45-degree field of view; 2352x1568px; color fundus photograph:
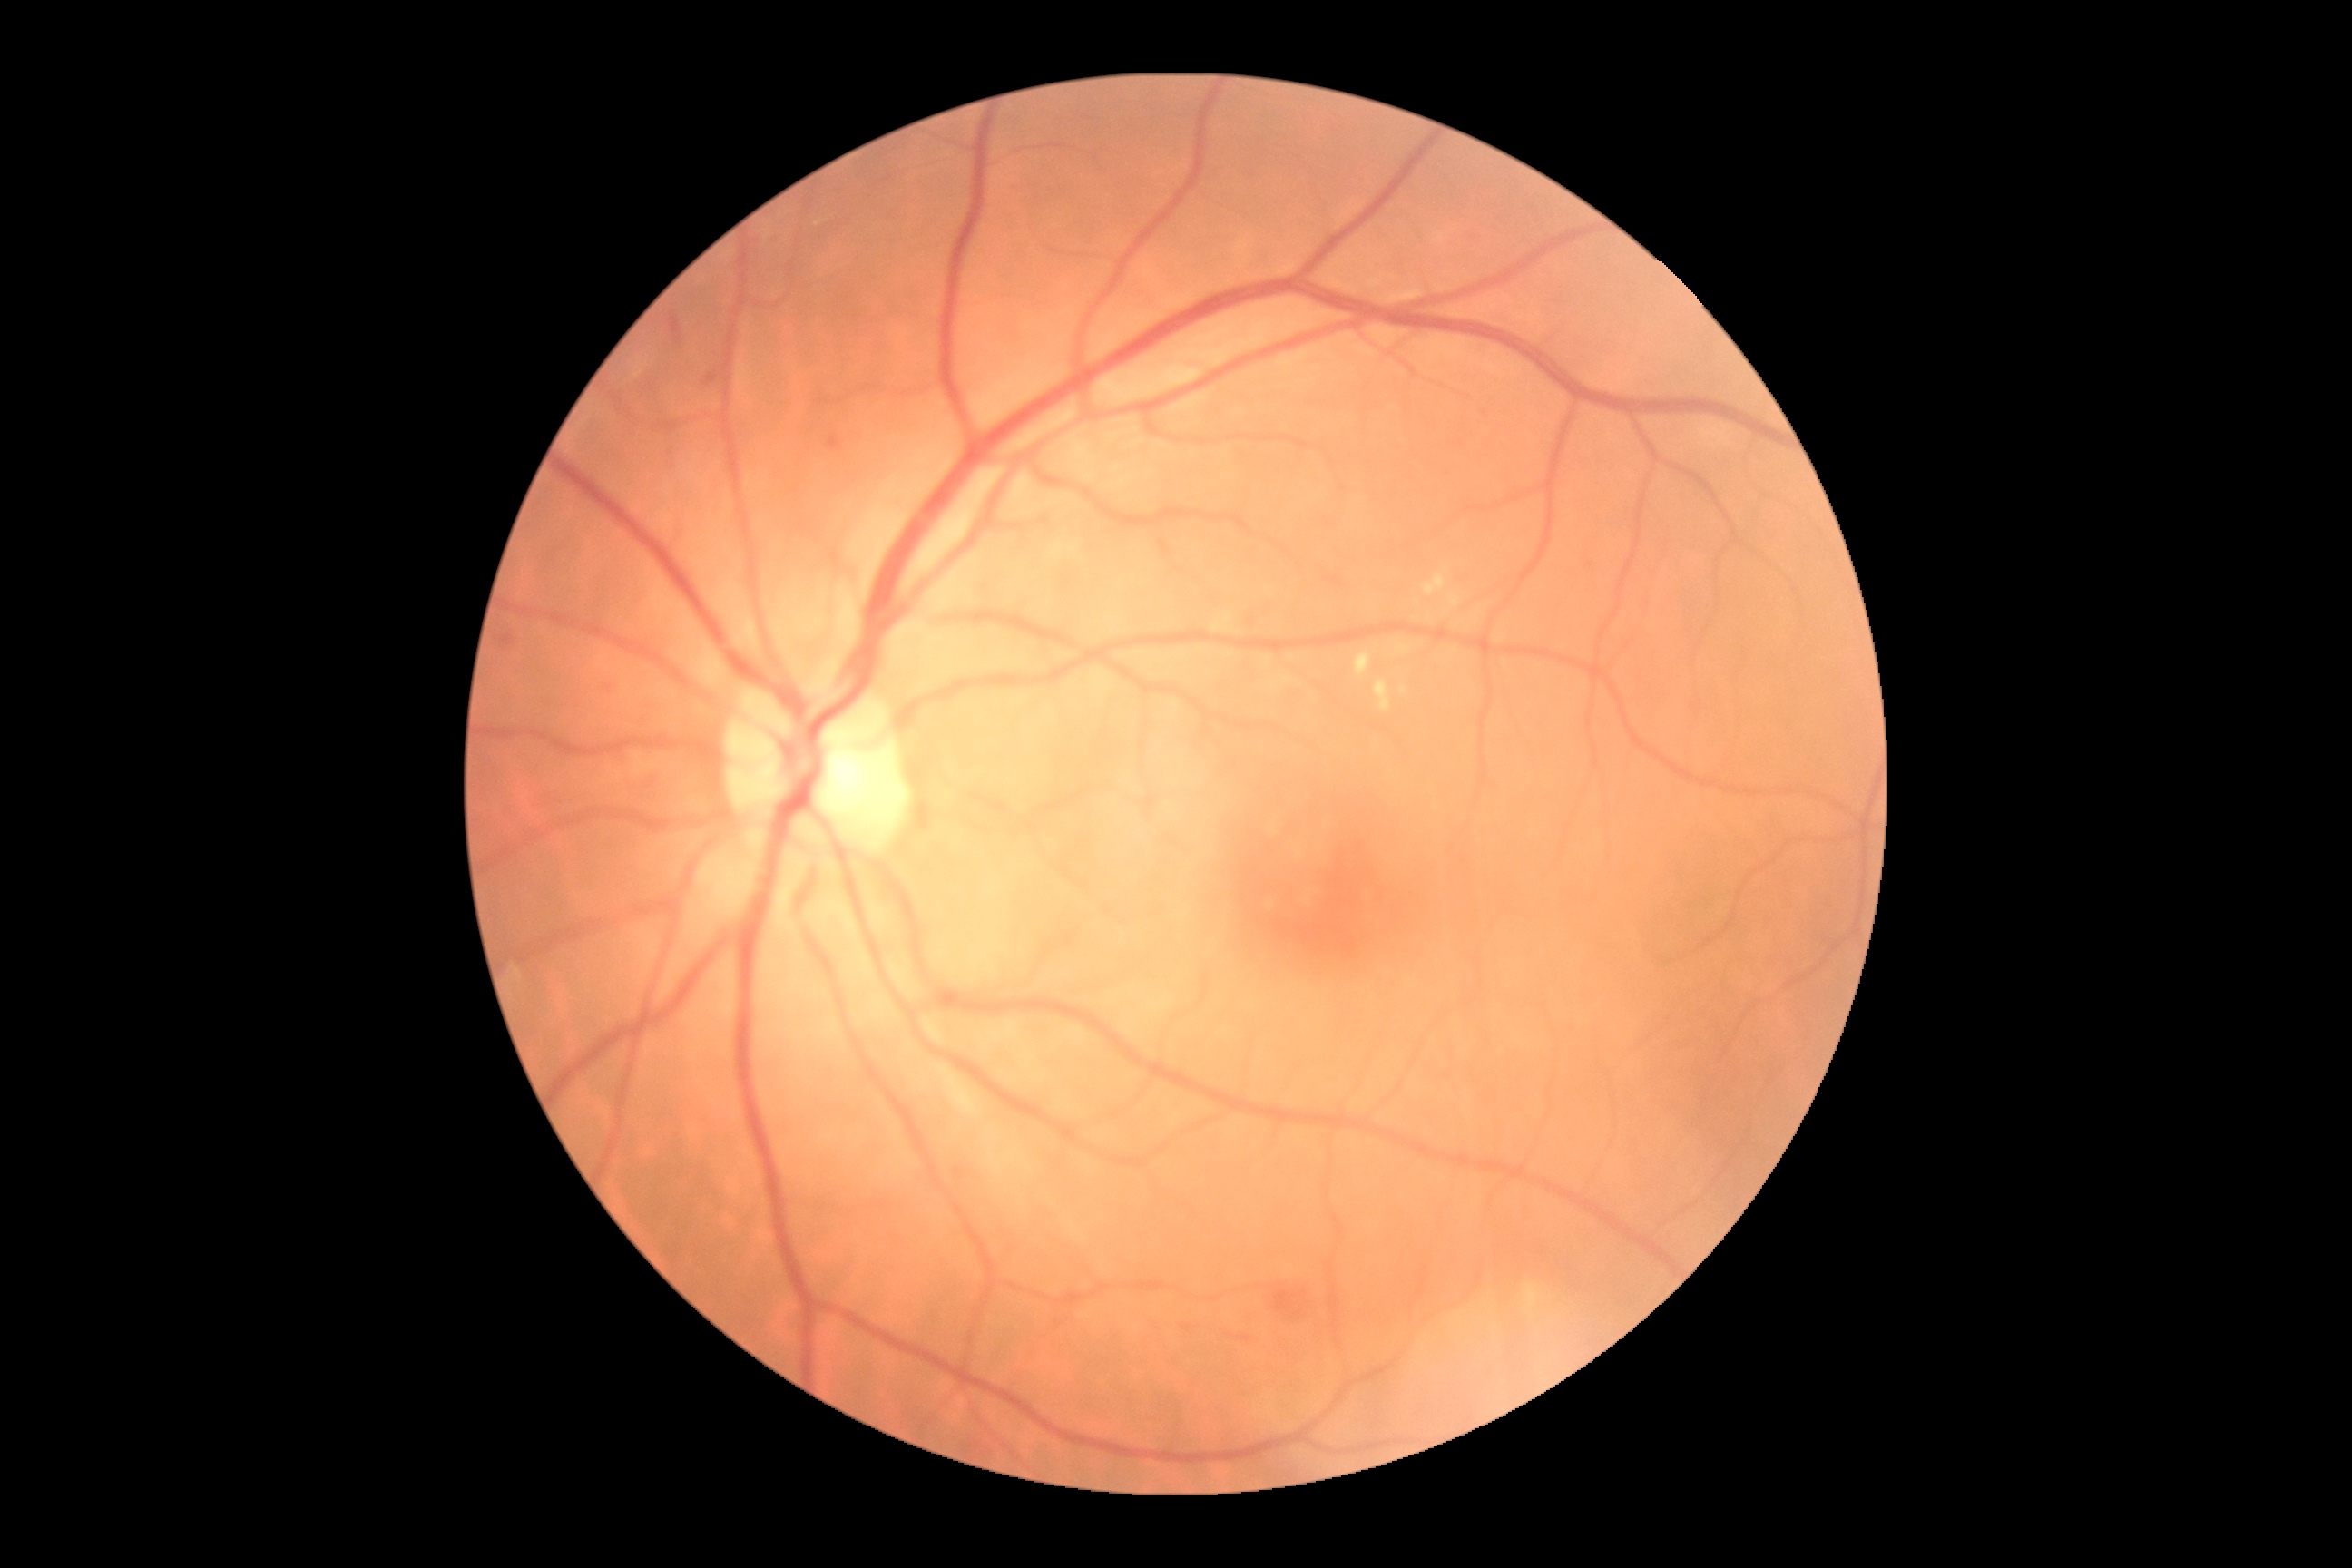

Diabetic retinopathy (DR): 2.
No soft exudates (SEs) identified.
No microaneurysms (MAs) identified.
Hemorrhages (HEs) are located at 1273/1288/1313/1328; 707/375/718/384; 500/636/513/645; 827/435/841/449; 1224/1333/1259/1346; 671/313/683/344; 1179/1315/1208/1338.
Hard exudates (EXs) (partial list) at 1451/649/1460/654; 1449/594/1462/609; 1424/573/1447/598; 1355/652/1371/678; 1475/614/1480/622; 1396/645/1411/654; 1375/681/1391/712.
Additional small EXs near {"x": 1403, "y": 690}.